Modified Davis grading; posterior pole photograph; nonmydriatic fundus photograph; NIDEK AFC-230 — 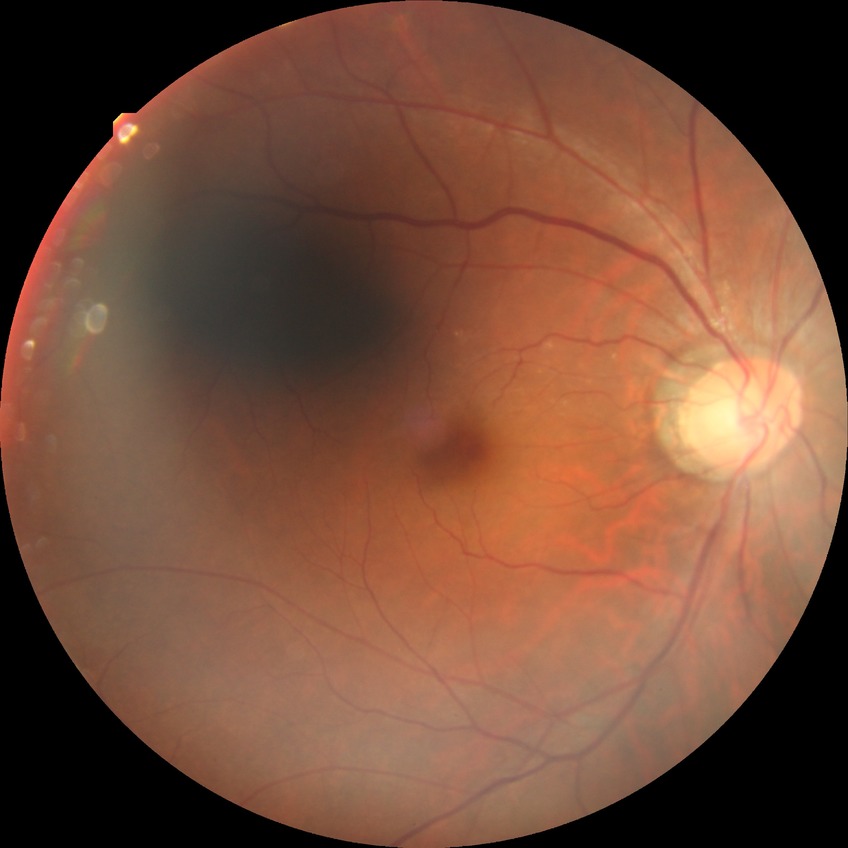
Retinopathy grade: no diabetic retinopathy.